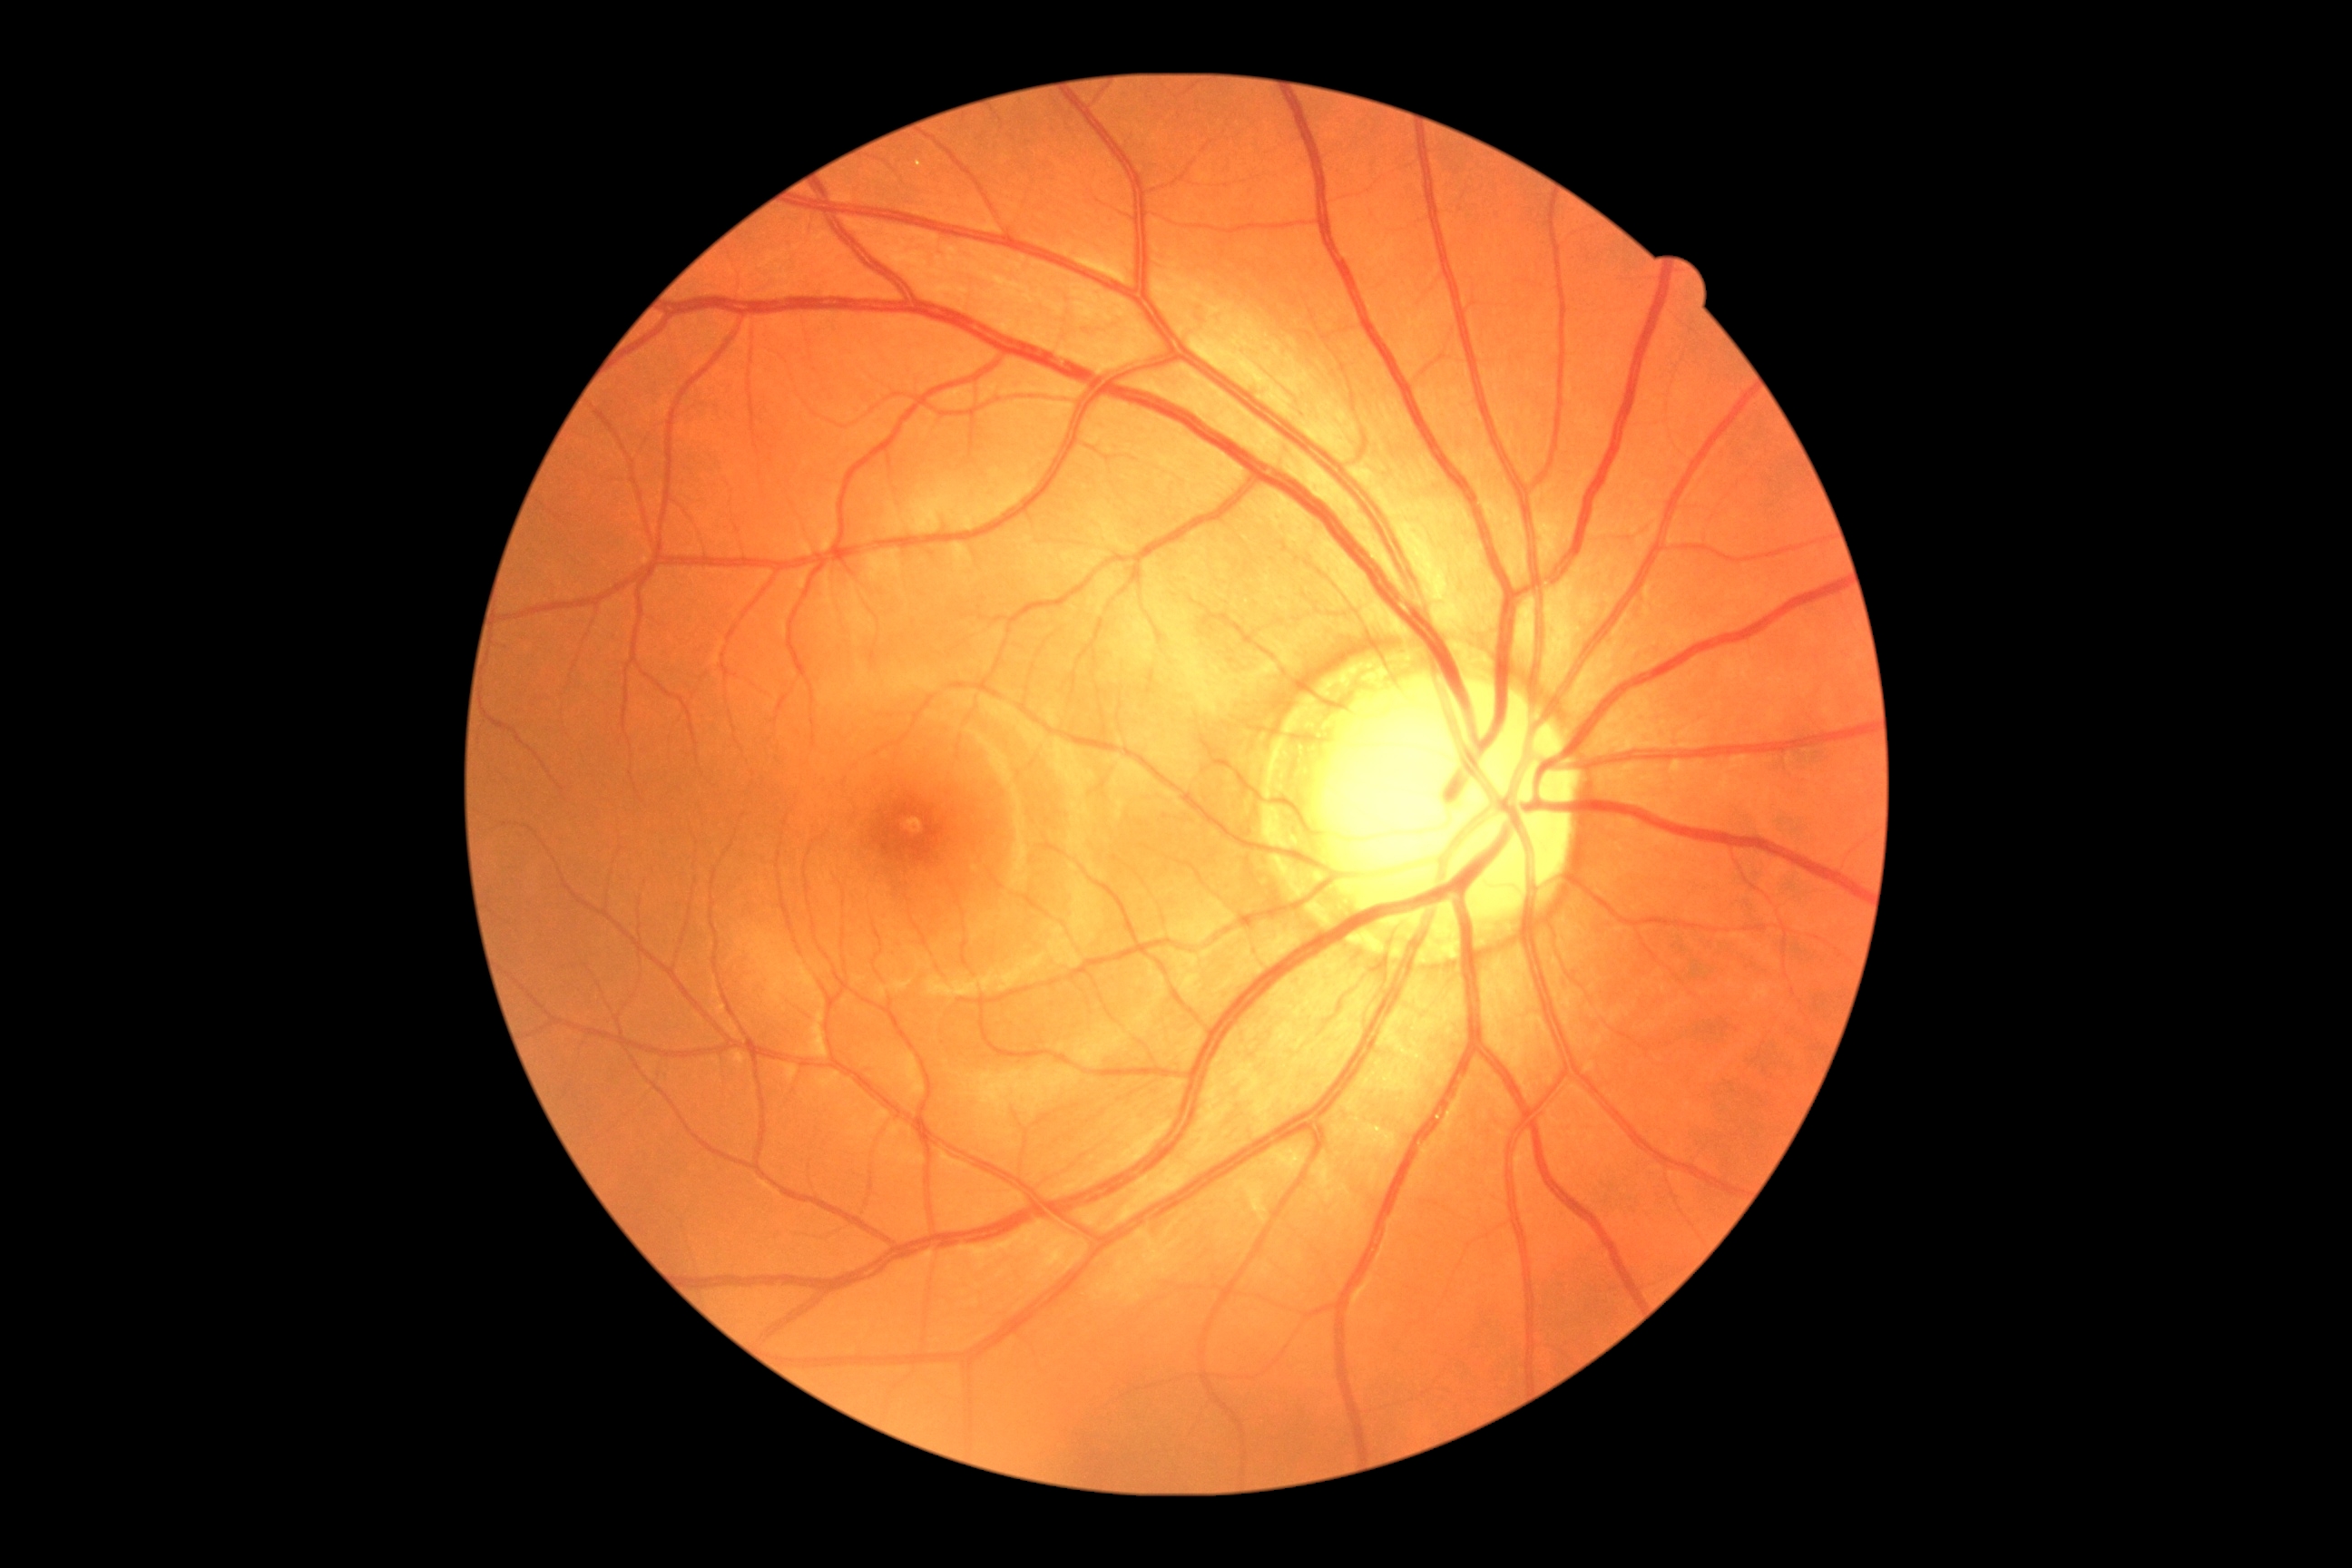

diabetic retinopathy (DR): 0/4.